Topcon TRC-50DX
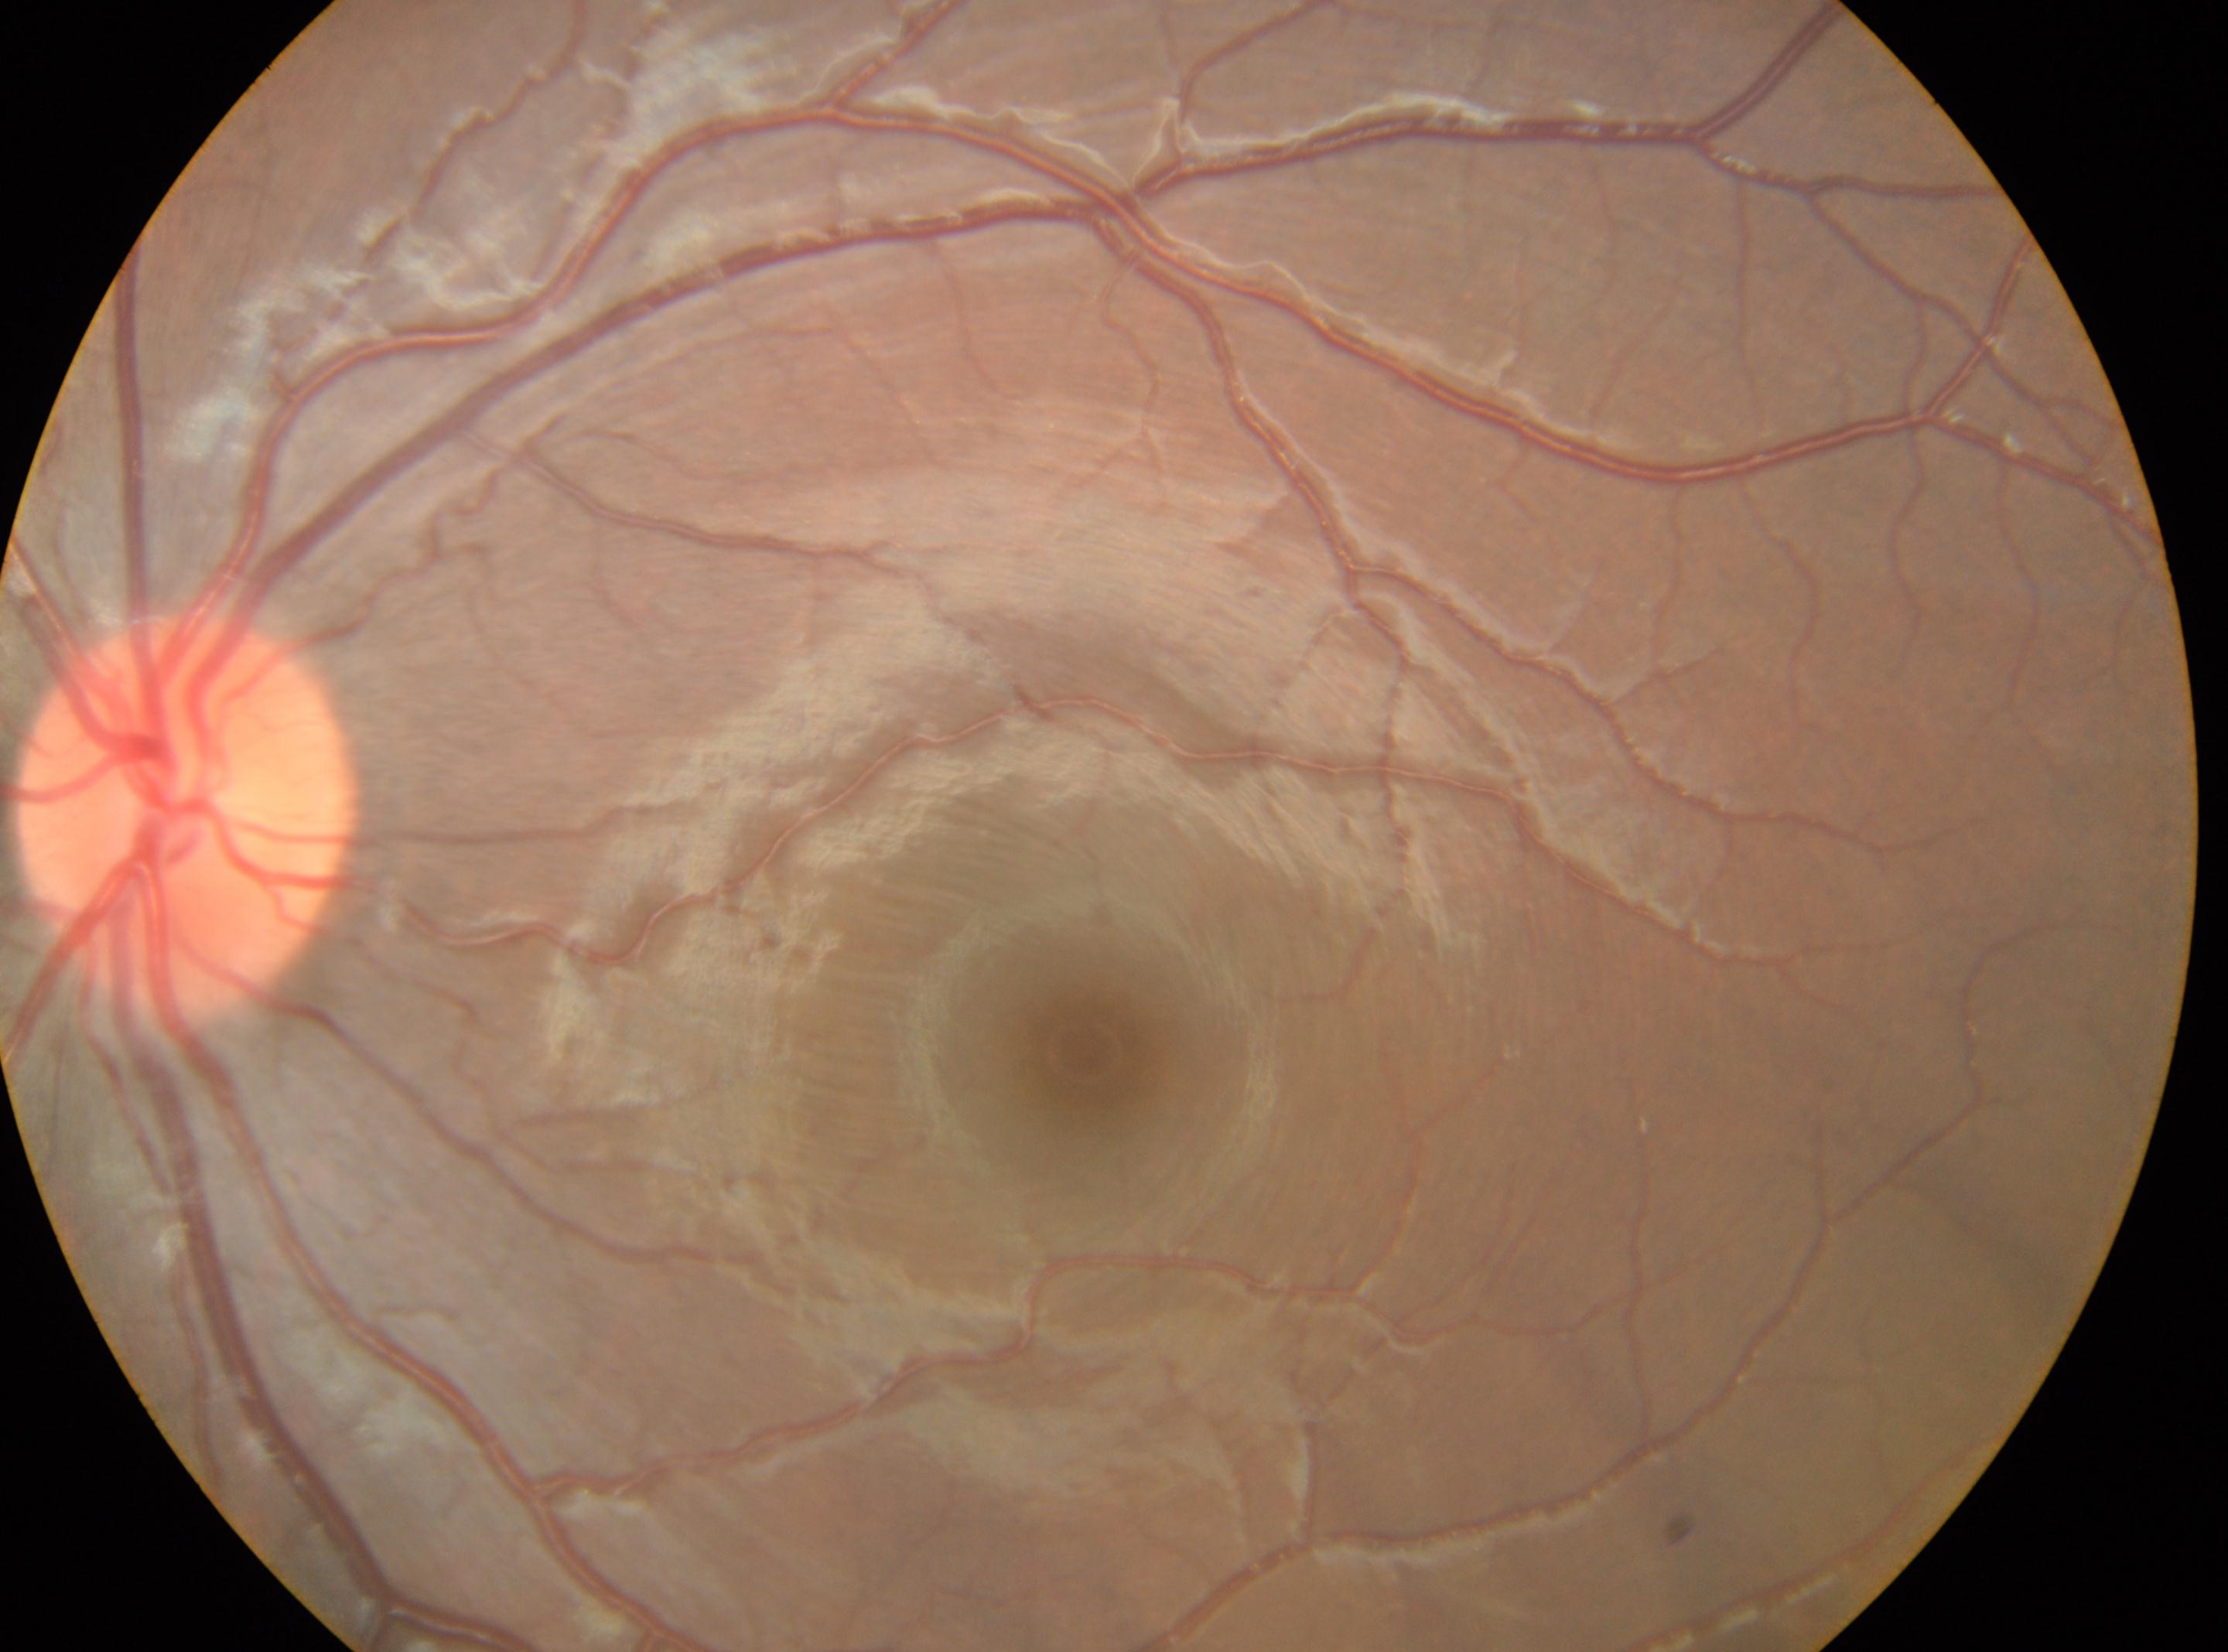 Fovea centralis: (1089, 1050).
DR grade: 0 (no apparent retinopathy) — no visible signs of diabetic retinopathy.
This is the OS.
The optic disc center is at (187, 820).